FOV: 45 degrees.
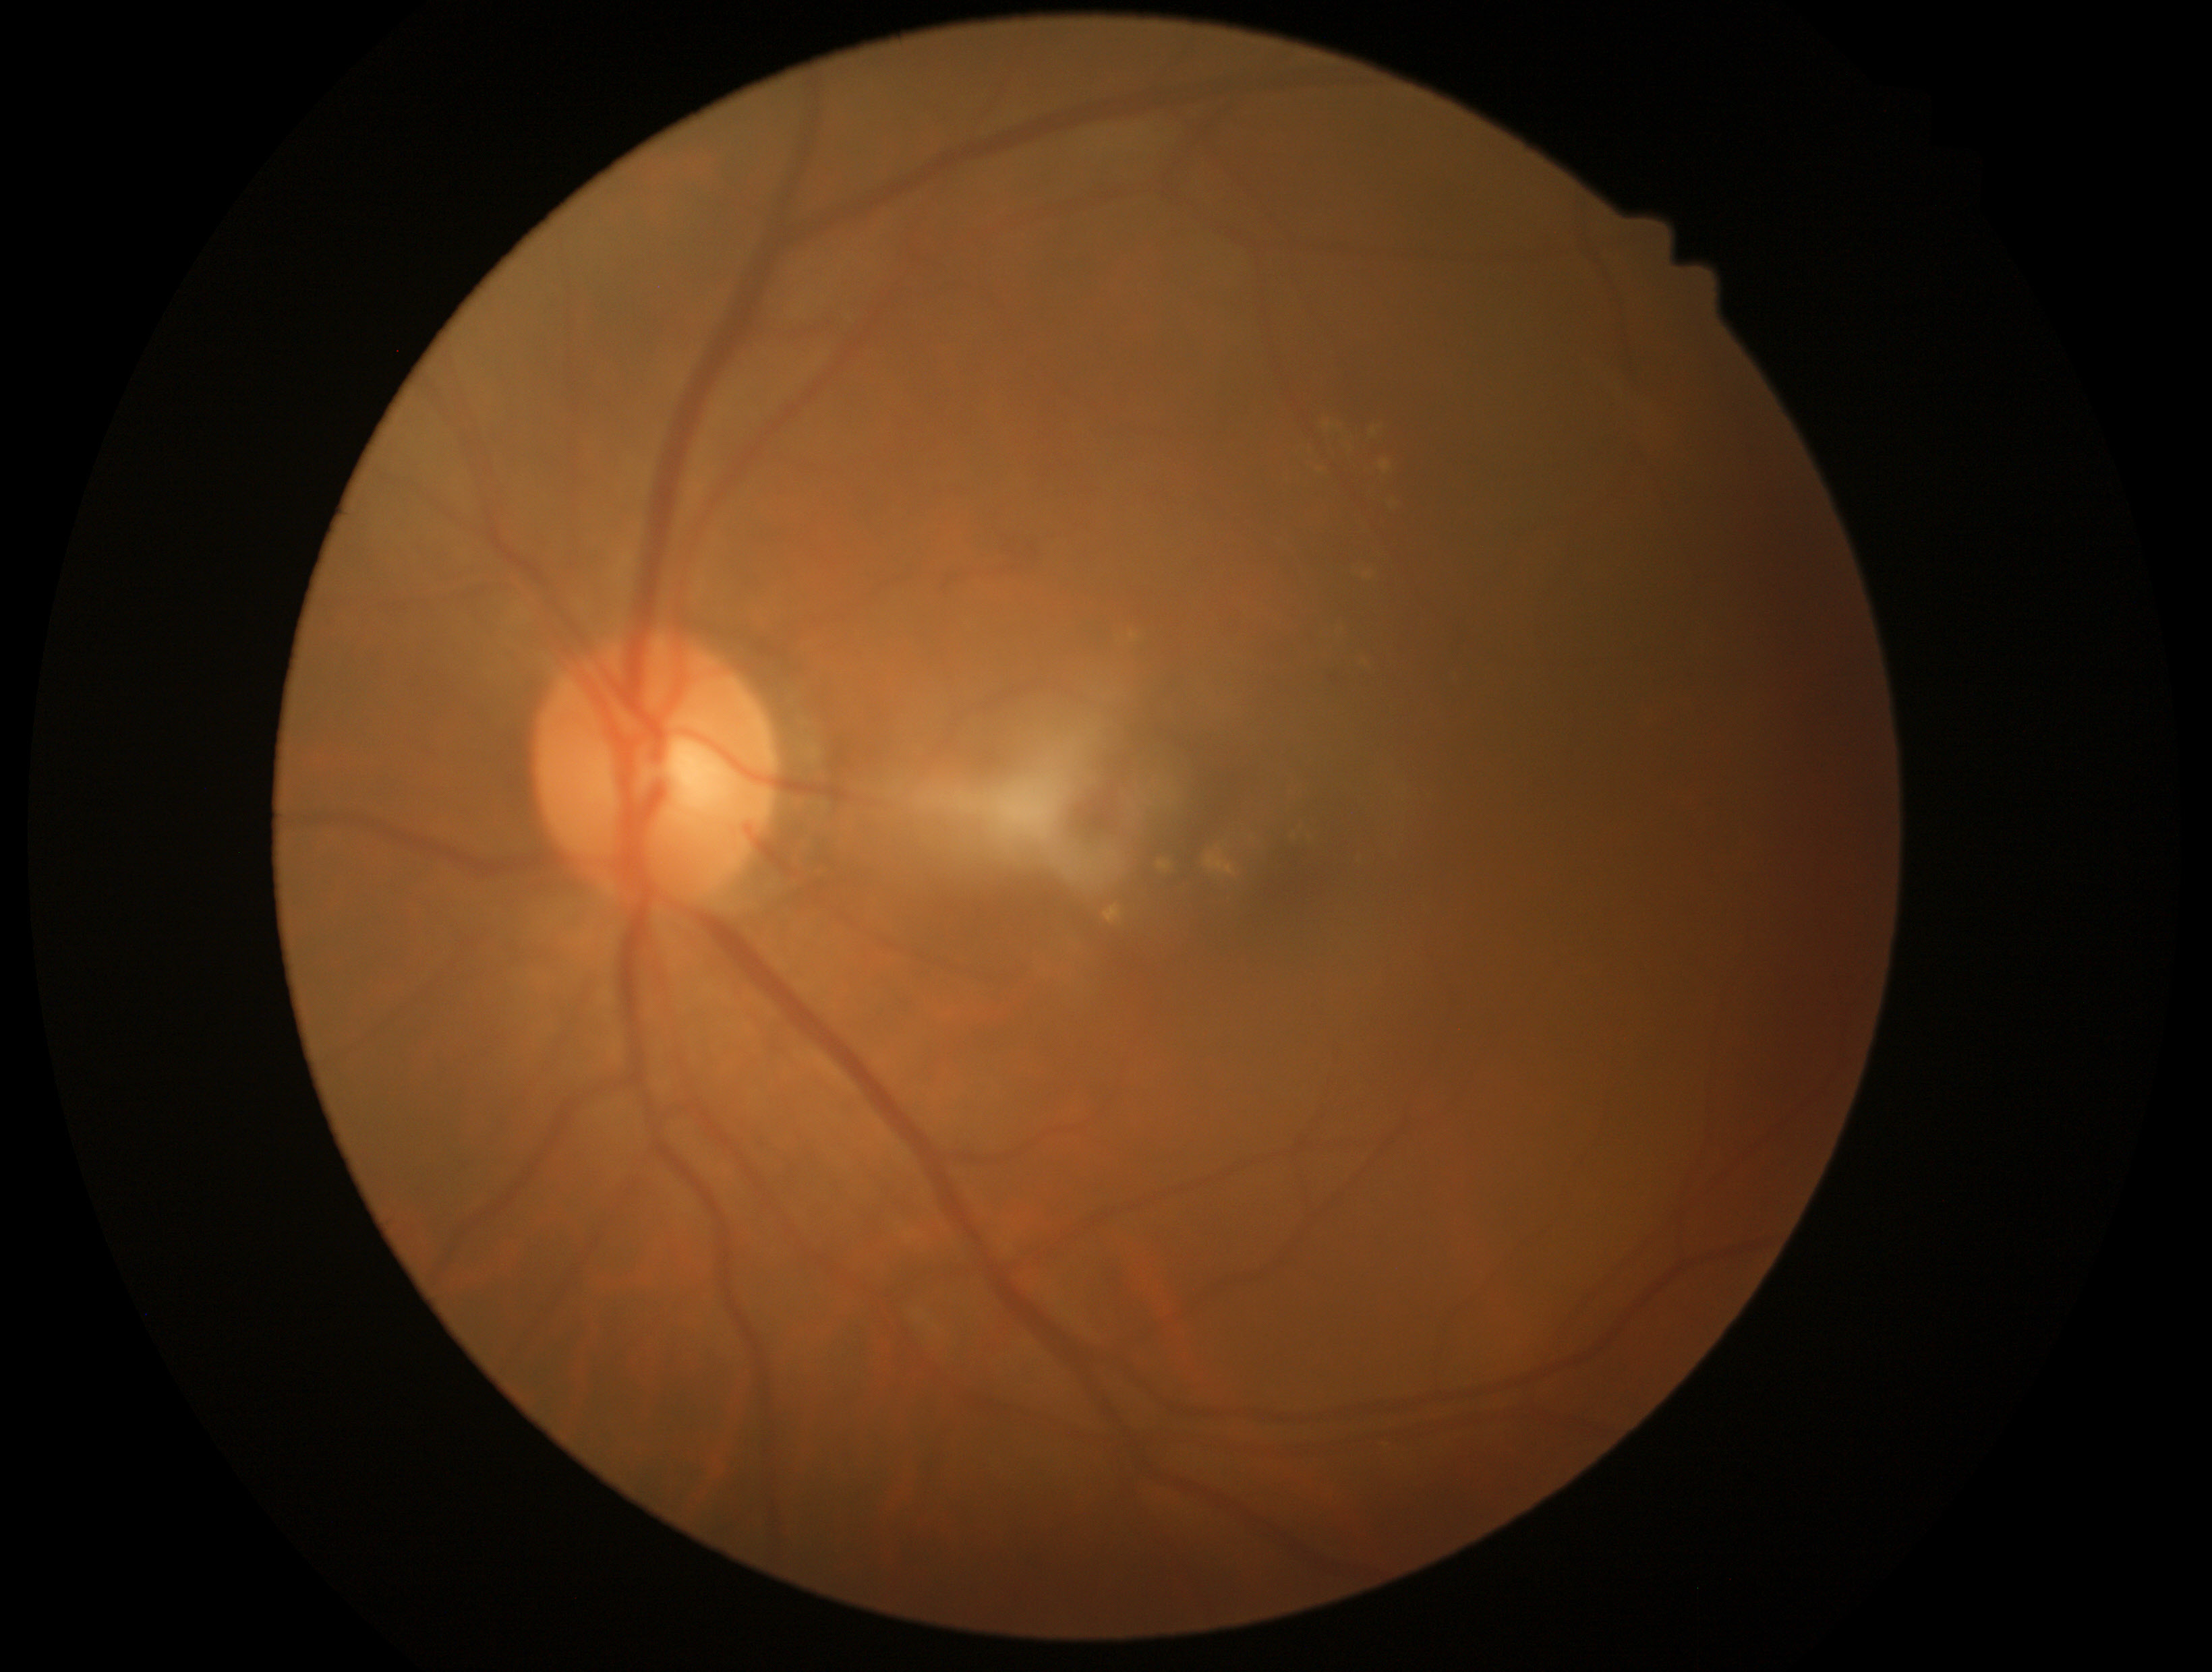 {"dr_grade": "2/4"}